Pediatric retinal photograph (wide-field). Captured with the Clarity RetCam 3 (130° field of view). 640 by 480 pixels:
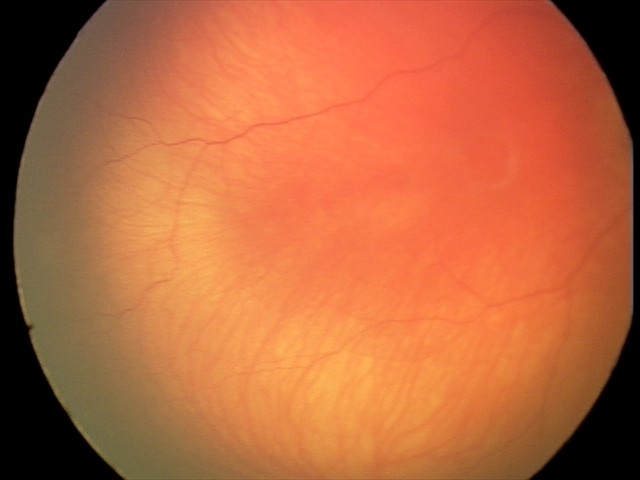 Q: What is the diagnosis from this examination?
A: normal retinal appearance